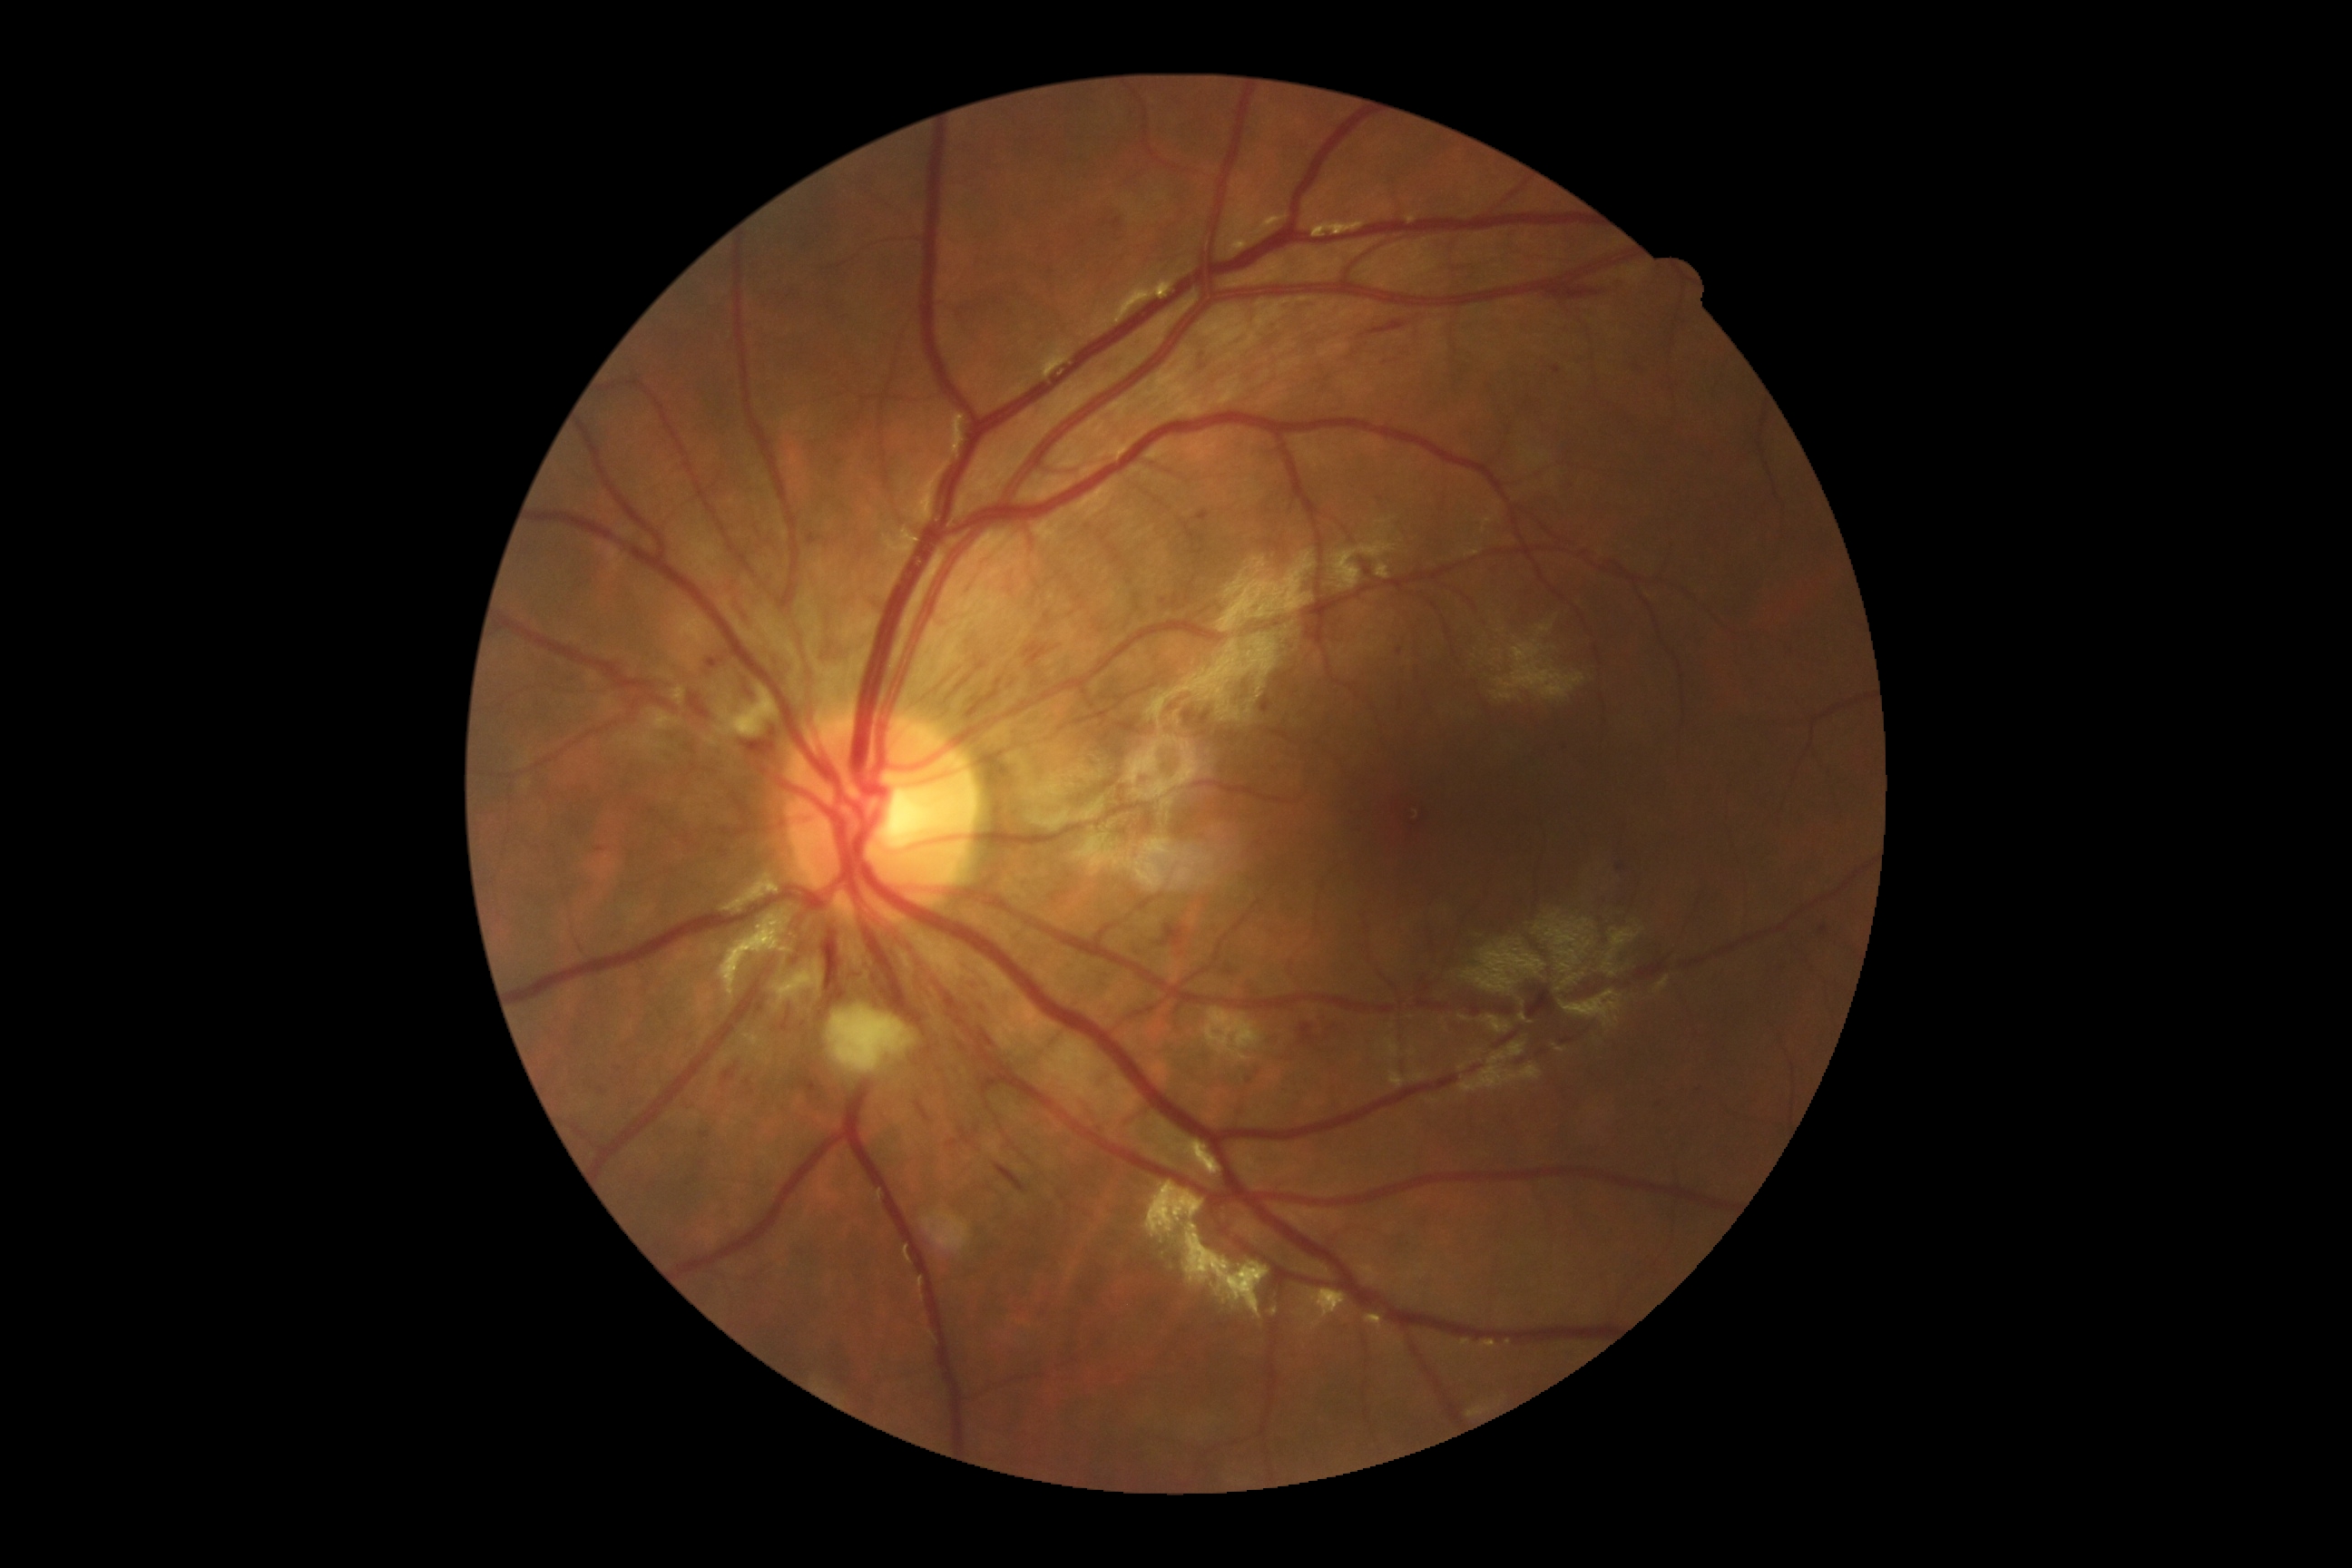 * DR: 2